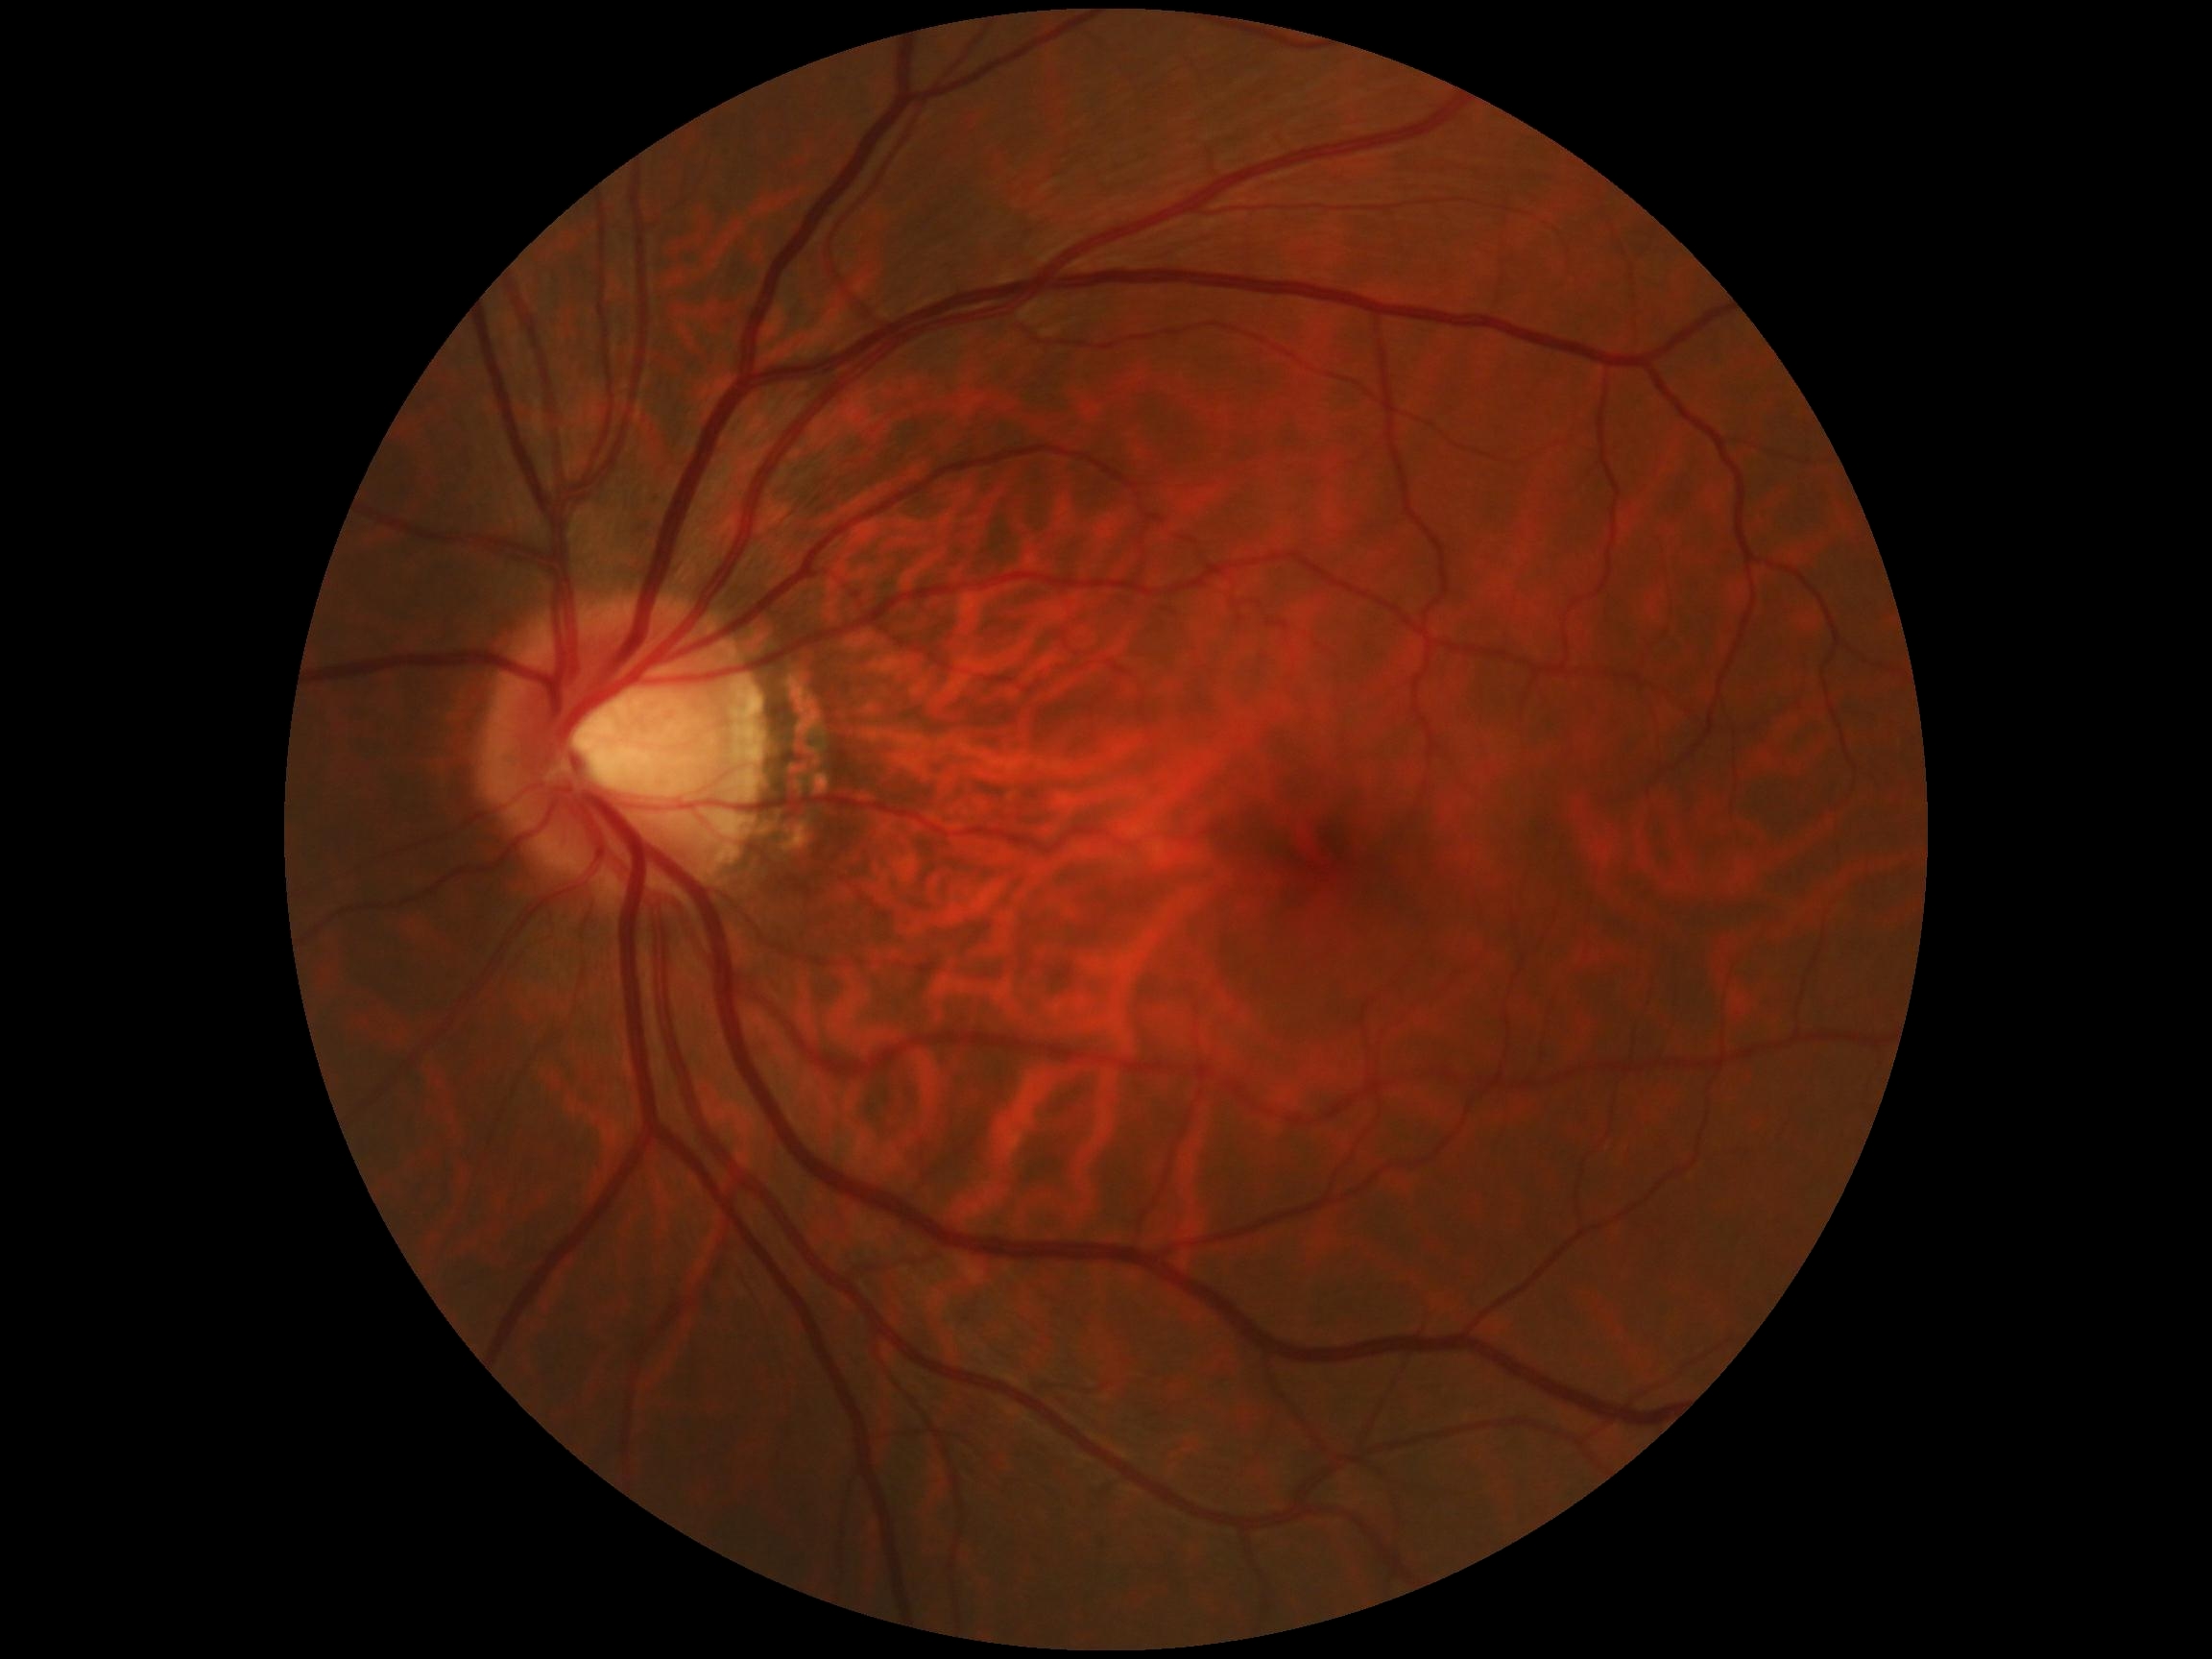
Diabetic retinopathy: grade 0 (no apparent retinopathy).